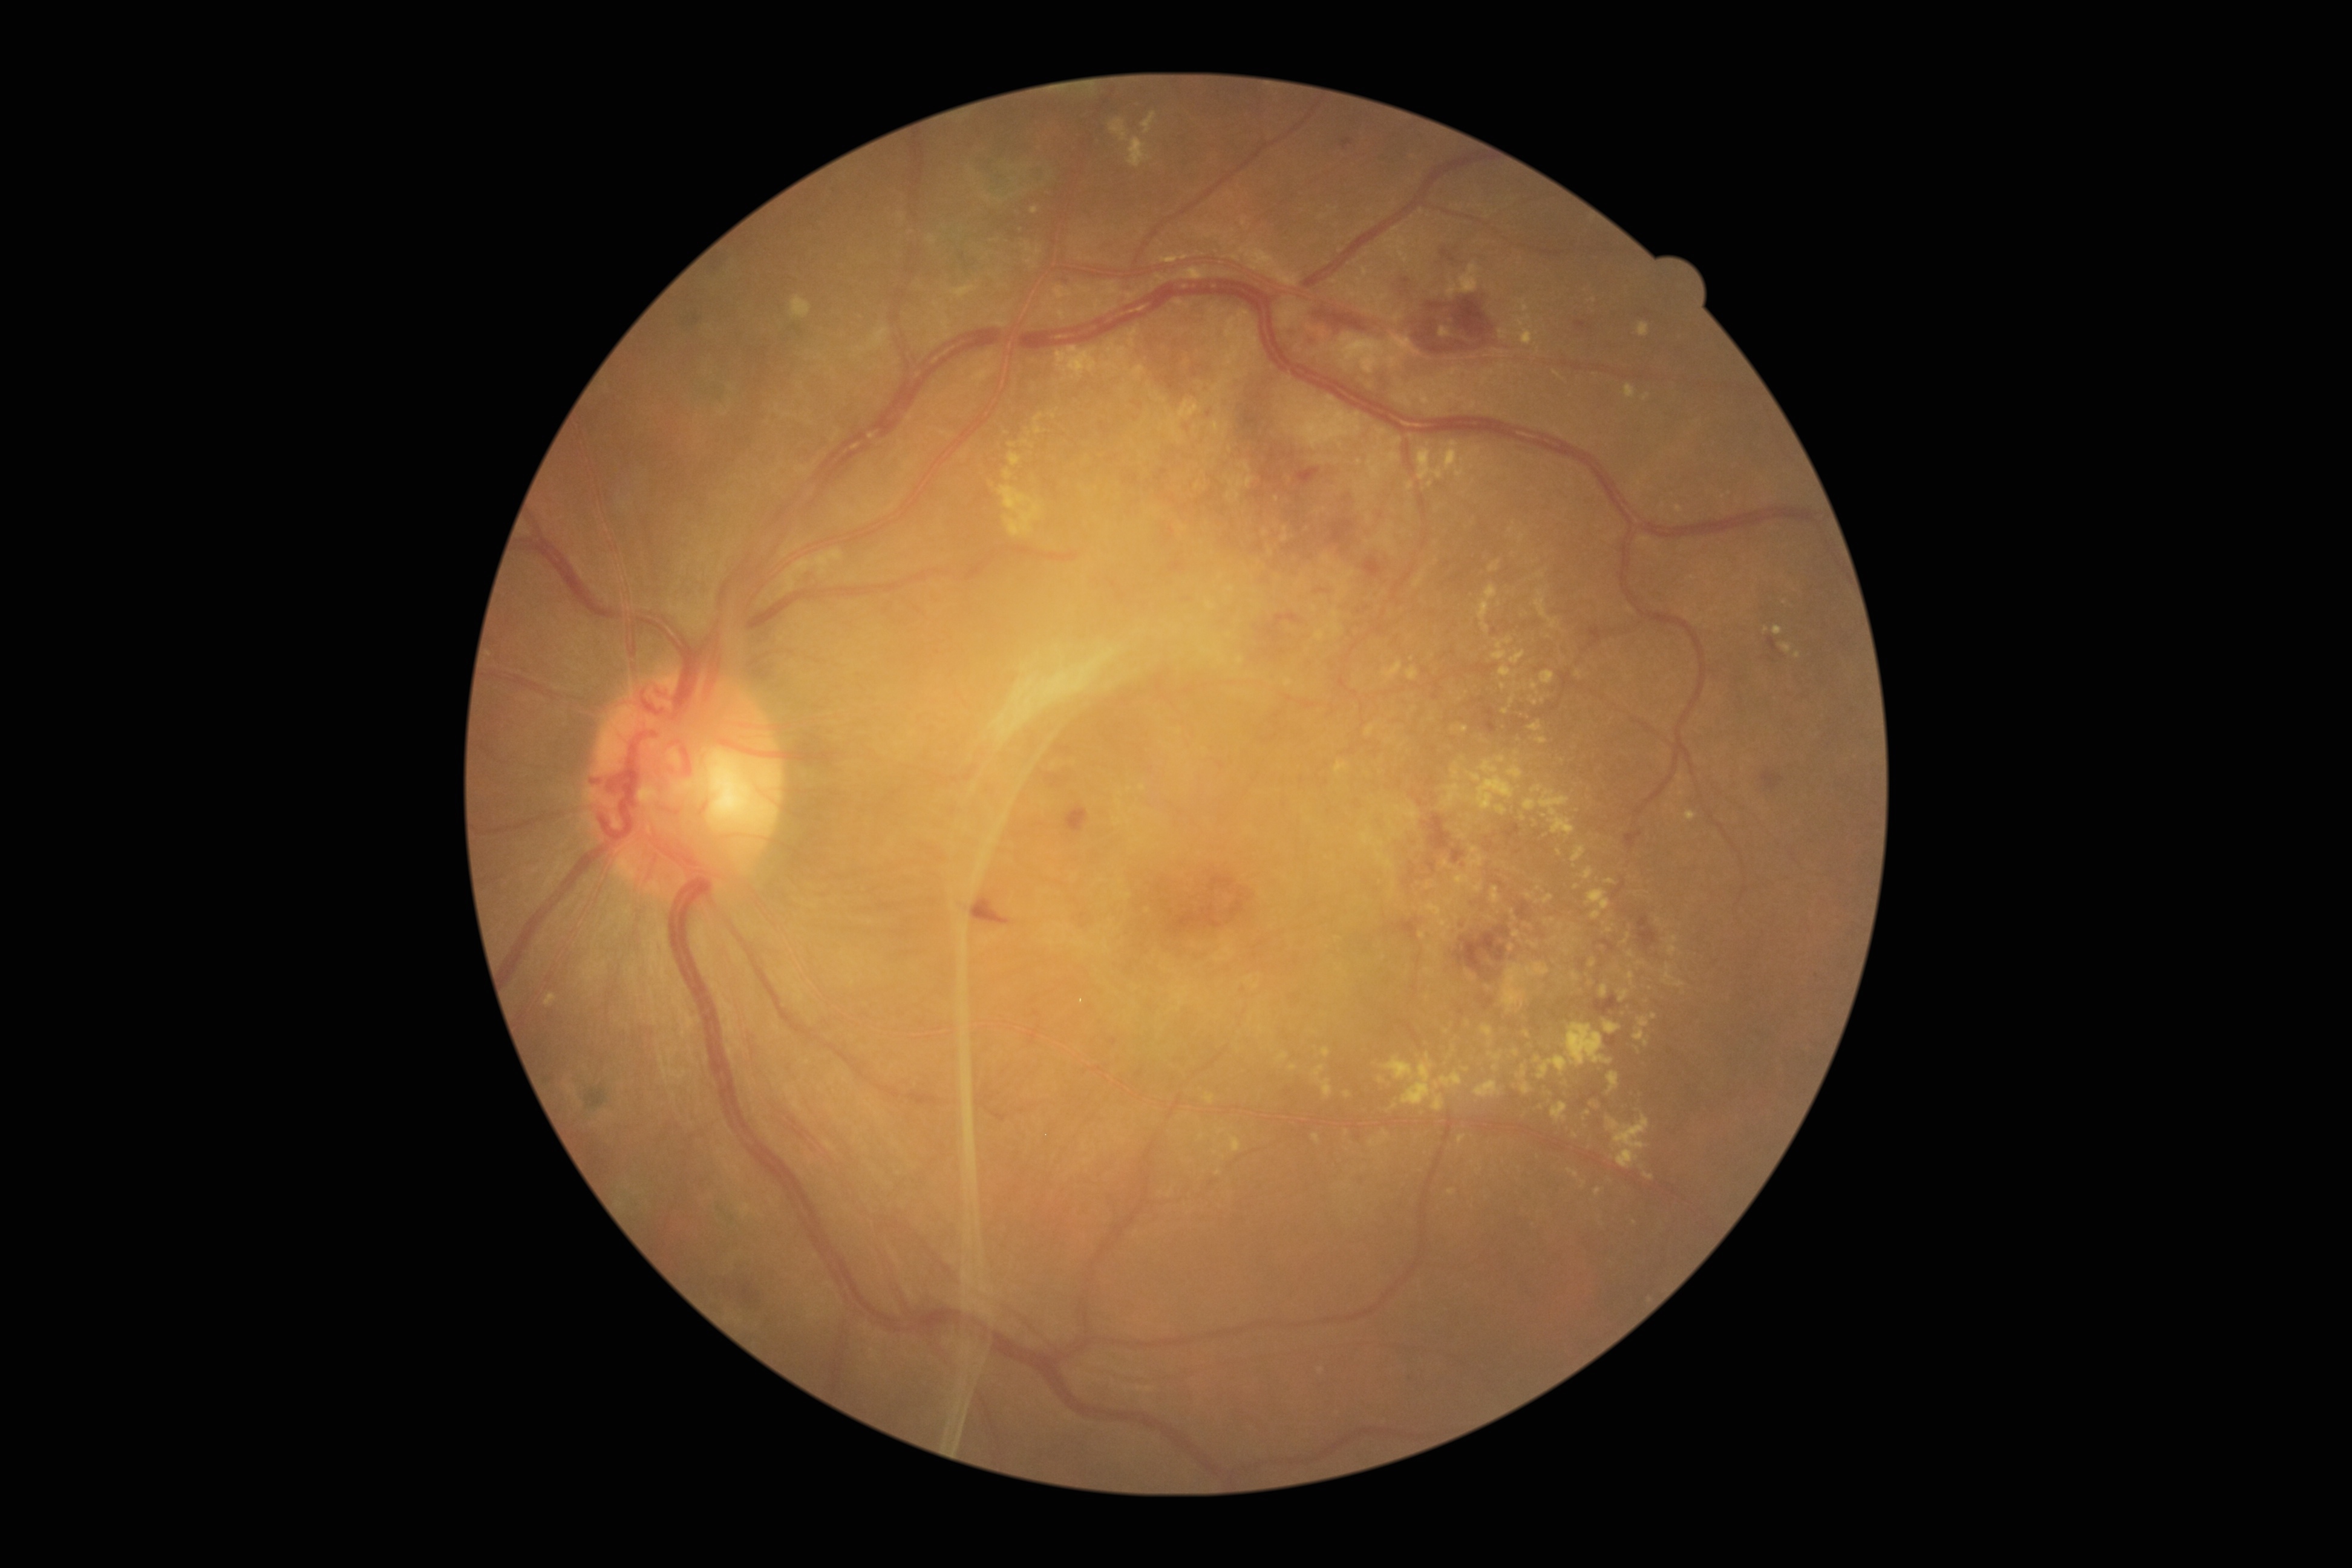
Retinopathy grade is PDR (4). The retinopathy is classified as proliferative diabetic retinopathy.